CFP.
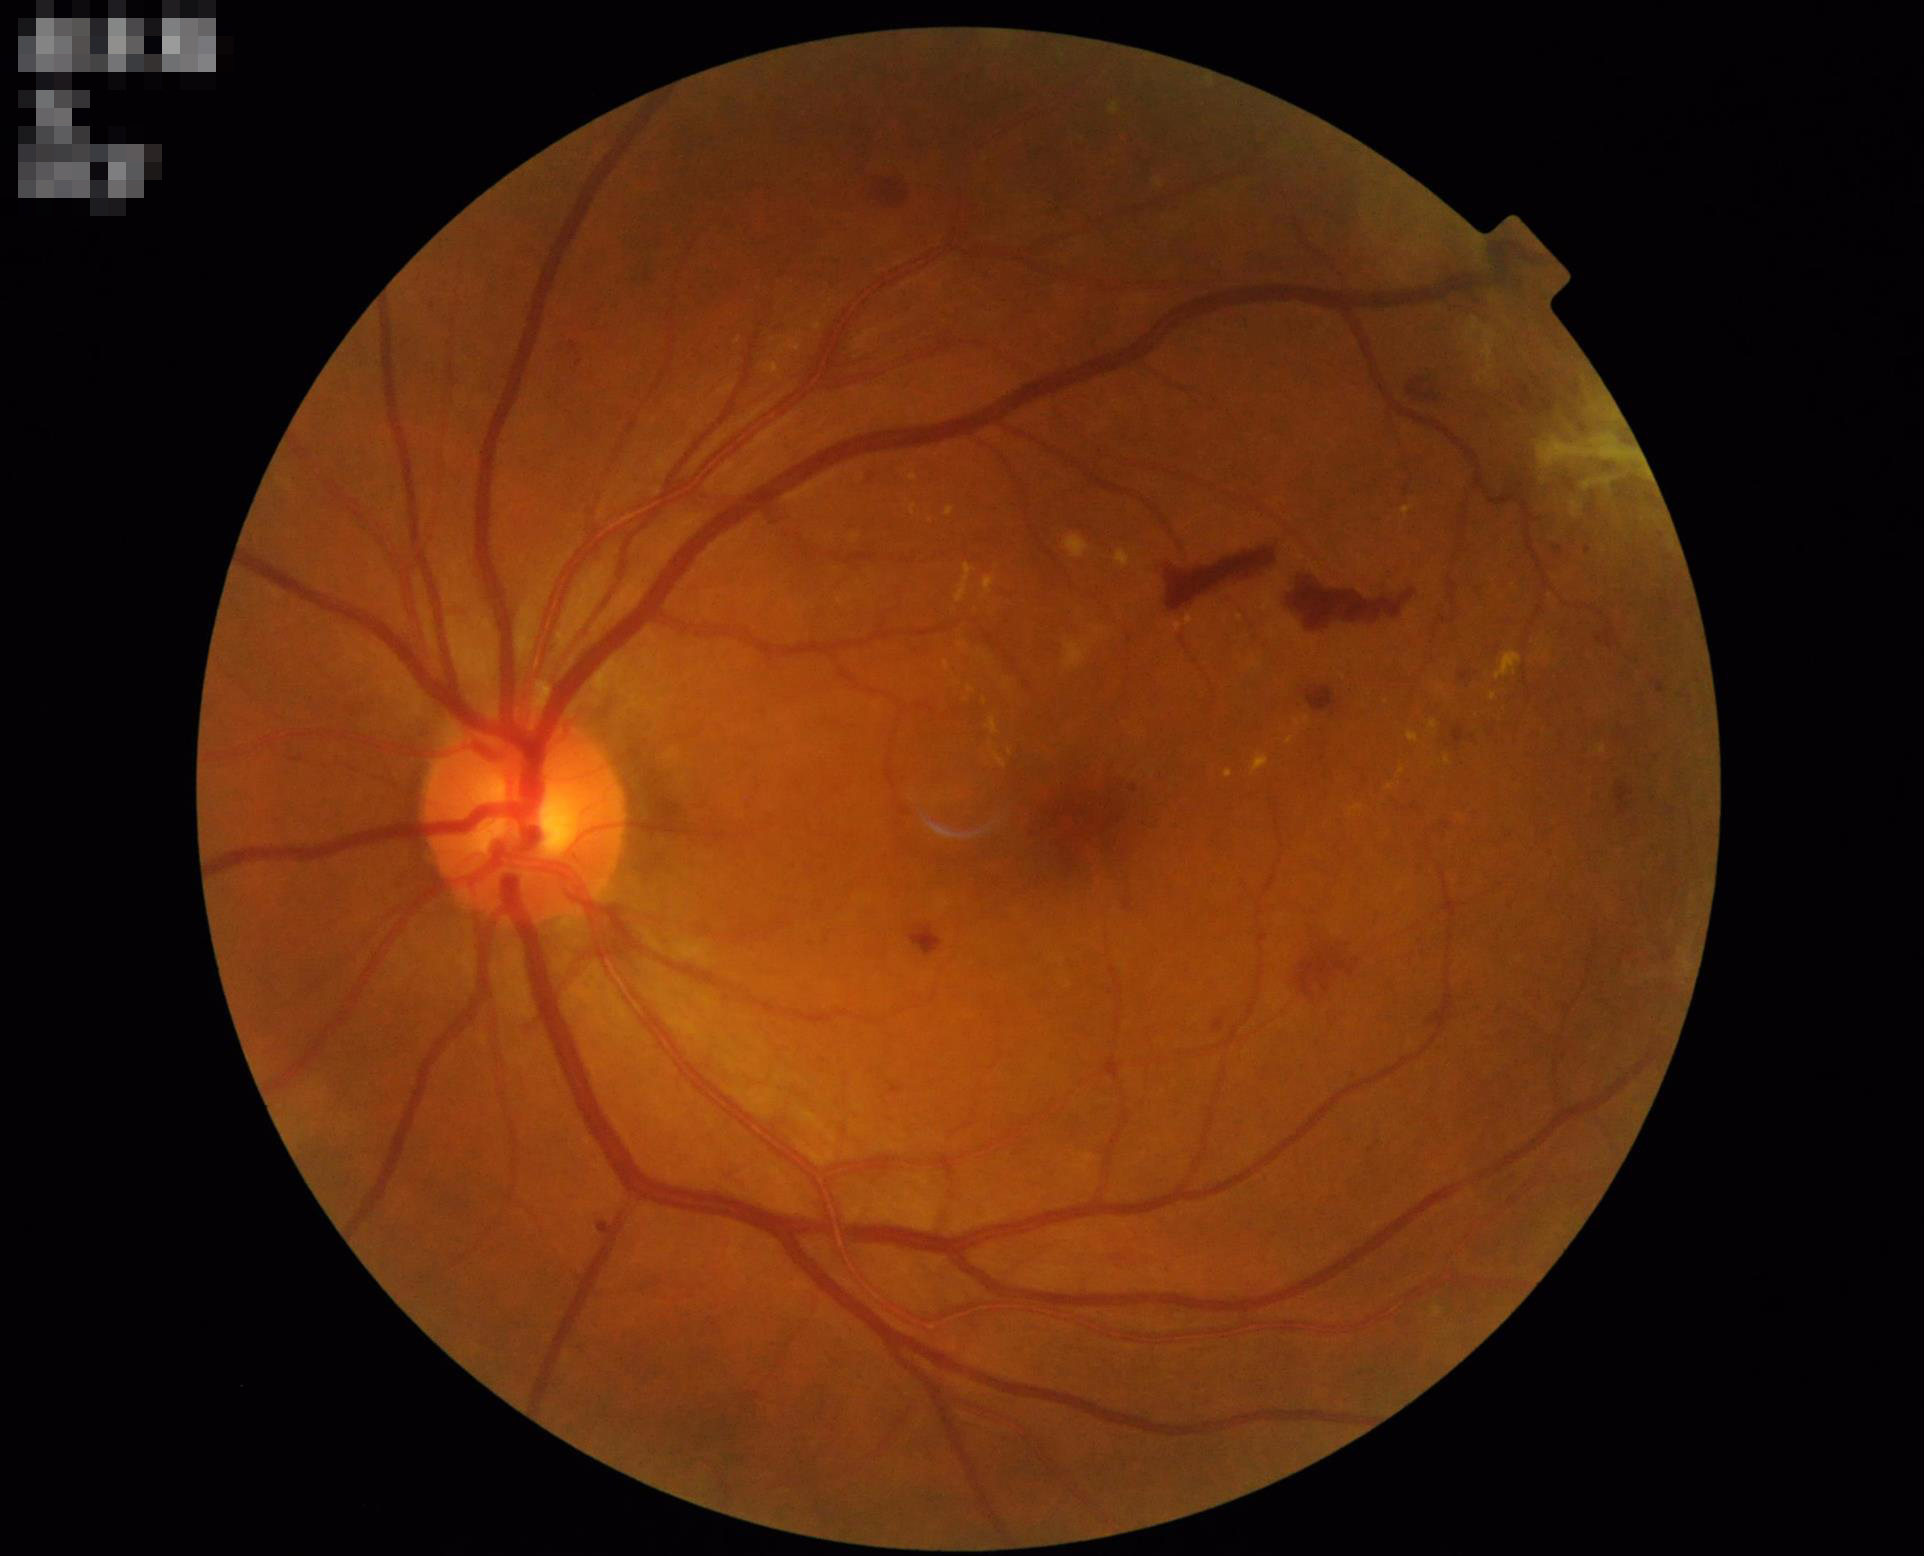

Image quality is adequate for diagnostic use. No over- or under-exposure. Optic disc, vessels, and background are in focus.